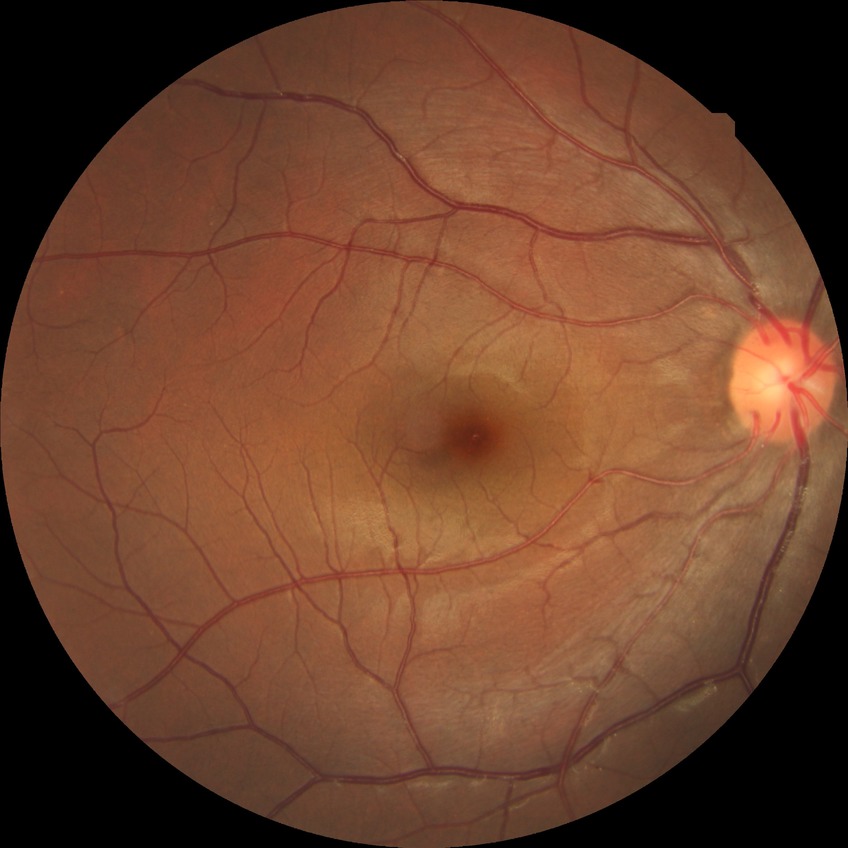

Davis grading@no diabetic retinopathy.